Retinal fundus photograph · 45° FOV · 2212 x 1659 pixels.
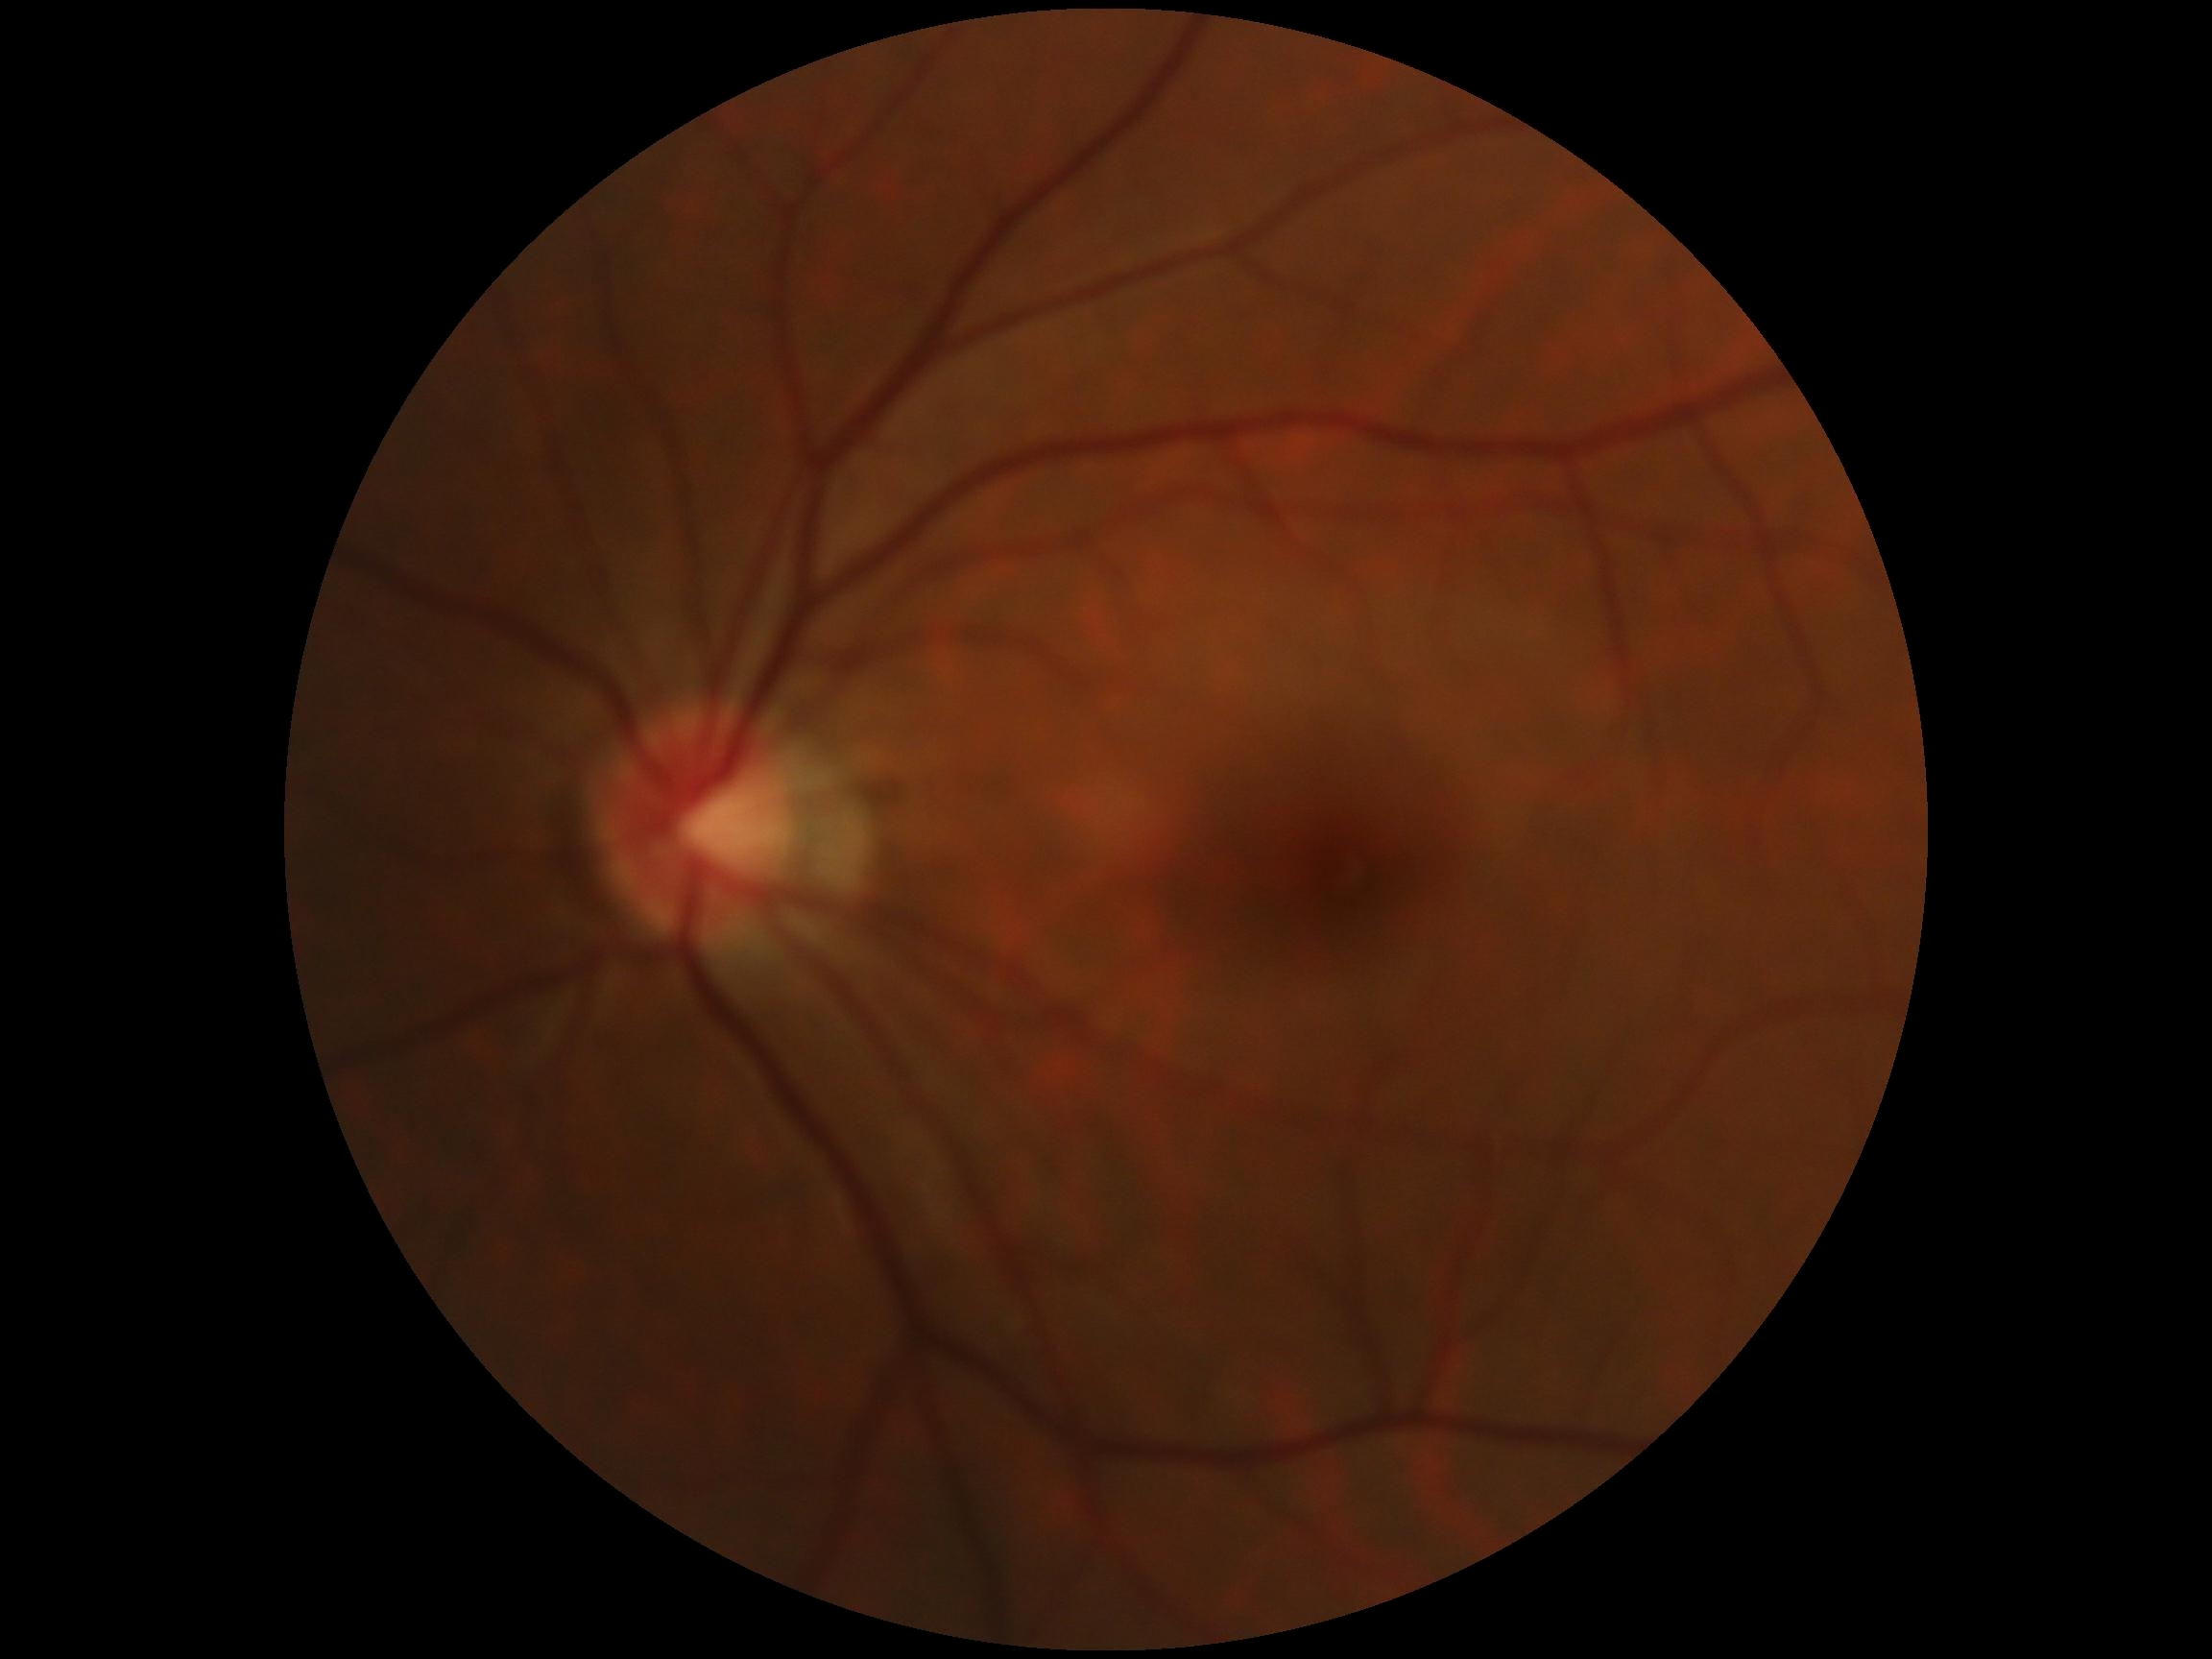
DR impression = no DR findings | diabetic retinopathy severity = grade 0 (no apparent retinopathy).